2184x1690px, 45° FOV — 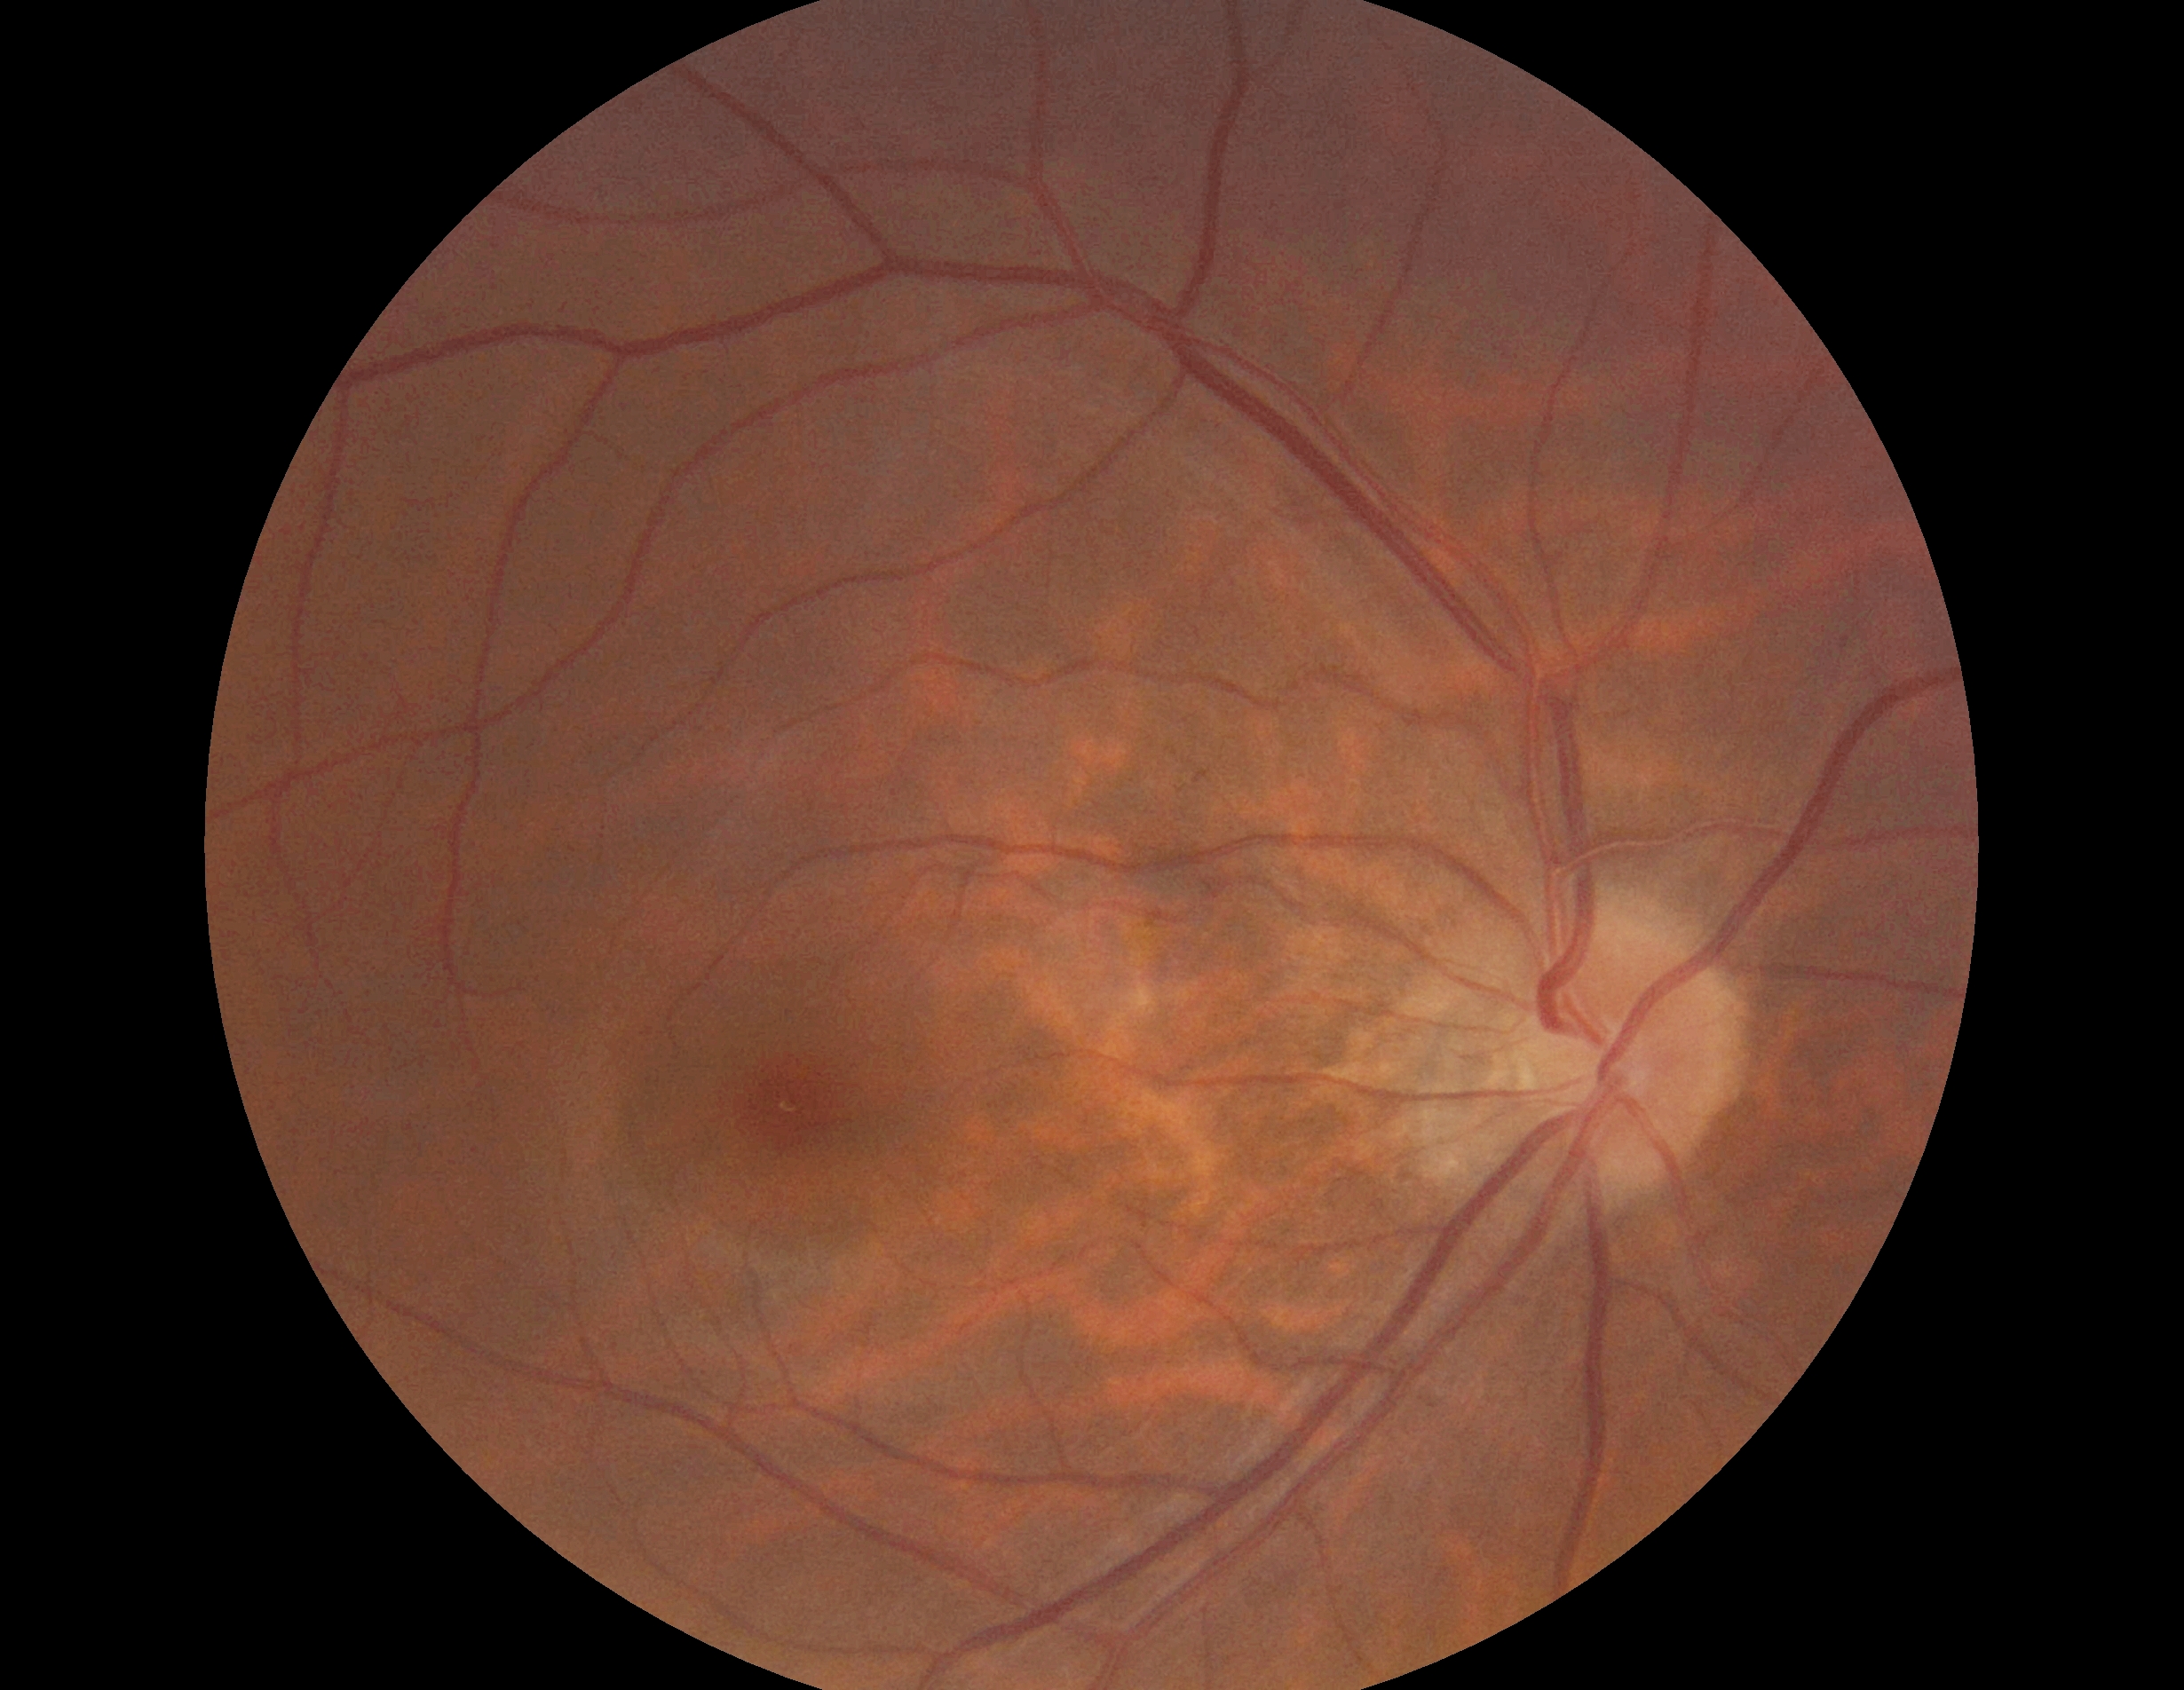

DR stage = grade 0
DR impression = negative for DR